CFP, 1920 by 1440 pixels — 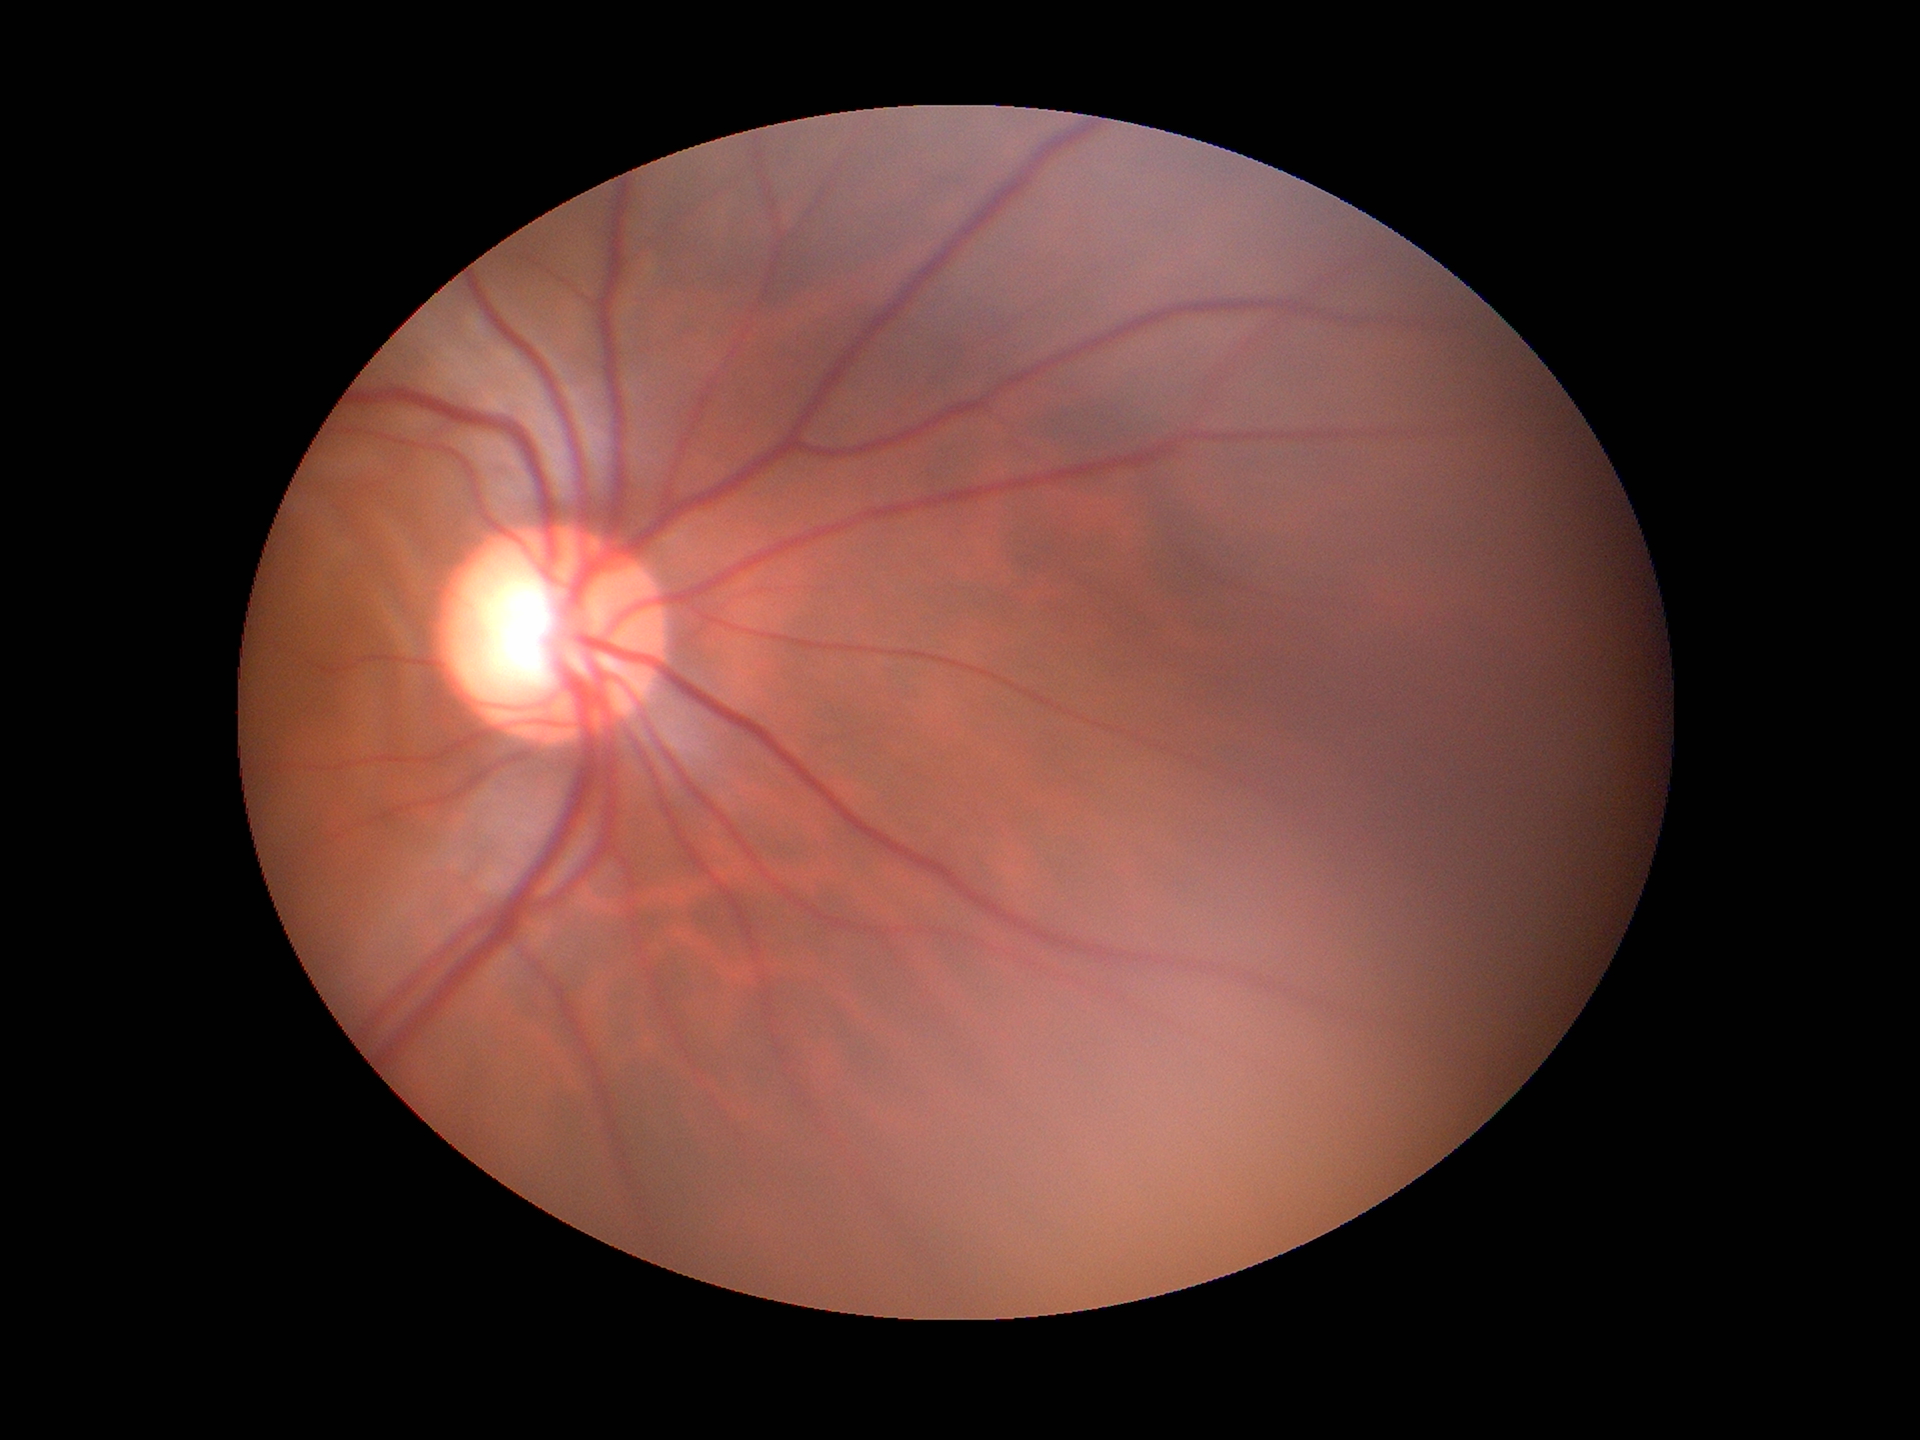
Q: What is the glaucoma assessment?
A: not suspect
Q: Vertical CDR?
A: 0.65
Q: What is the ACDR?
A: 0.35